Nonmydriatic · NIDEK AFC-230 · 45 degree fundus photograph
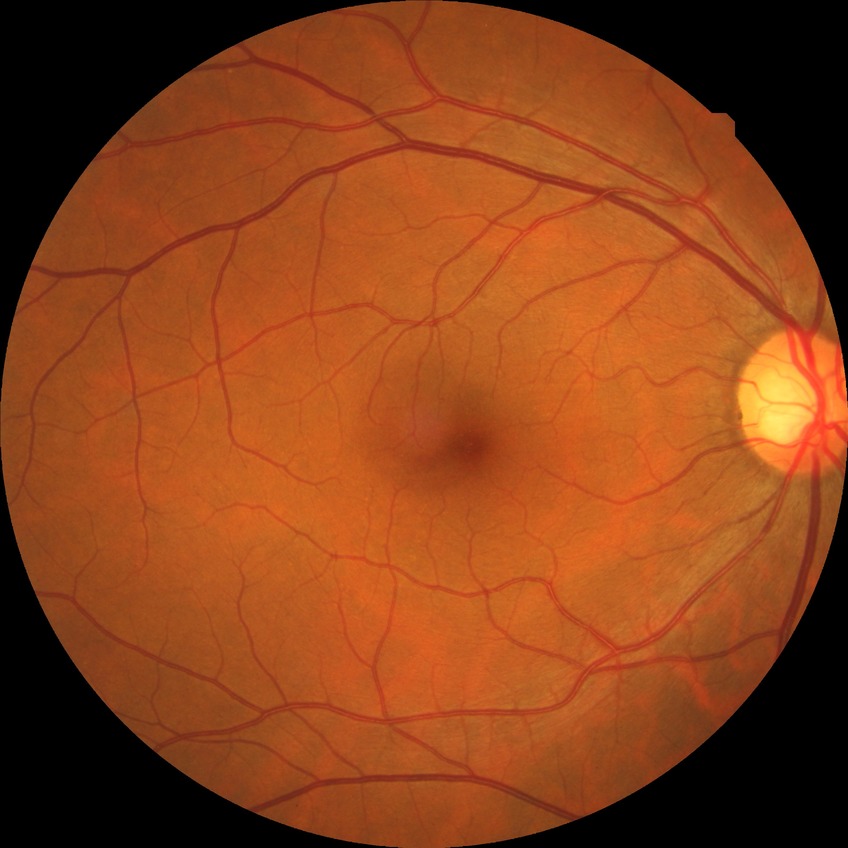
Diabetic retinopathy (DR): NDR (no diabetic retinopathy).